Wide-field contact fundus photograph of an infant. 1240x1240px:
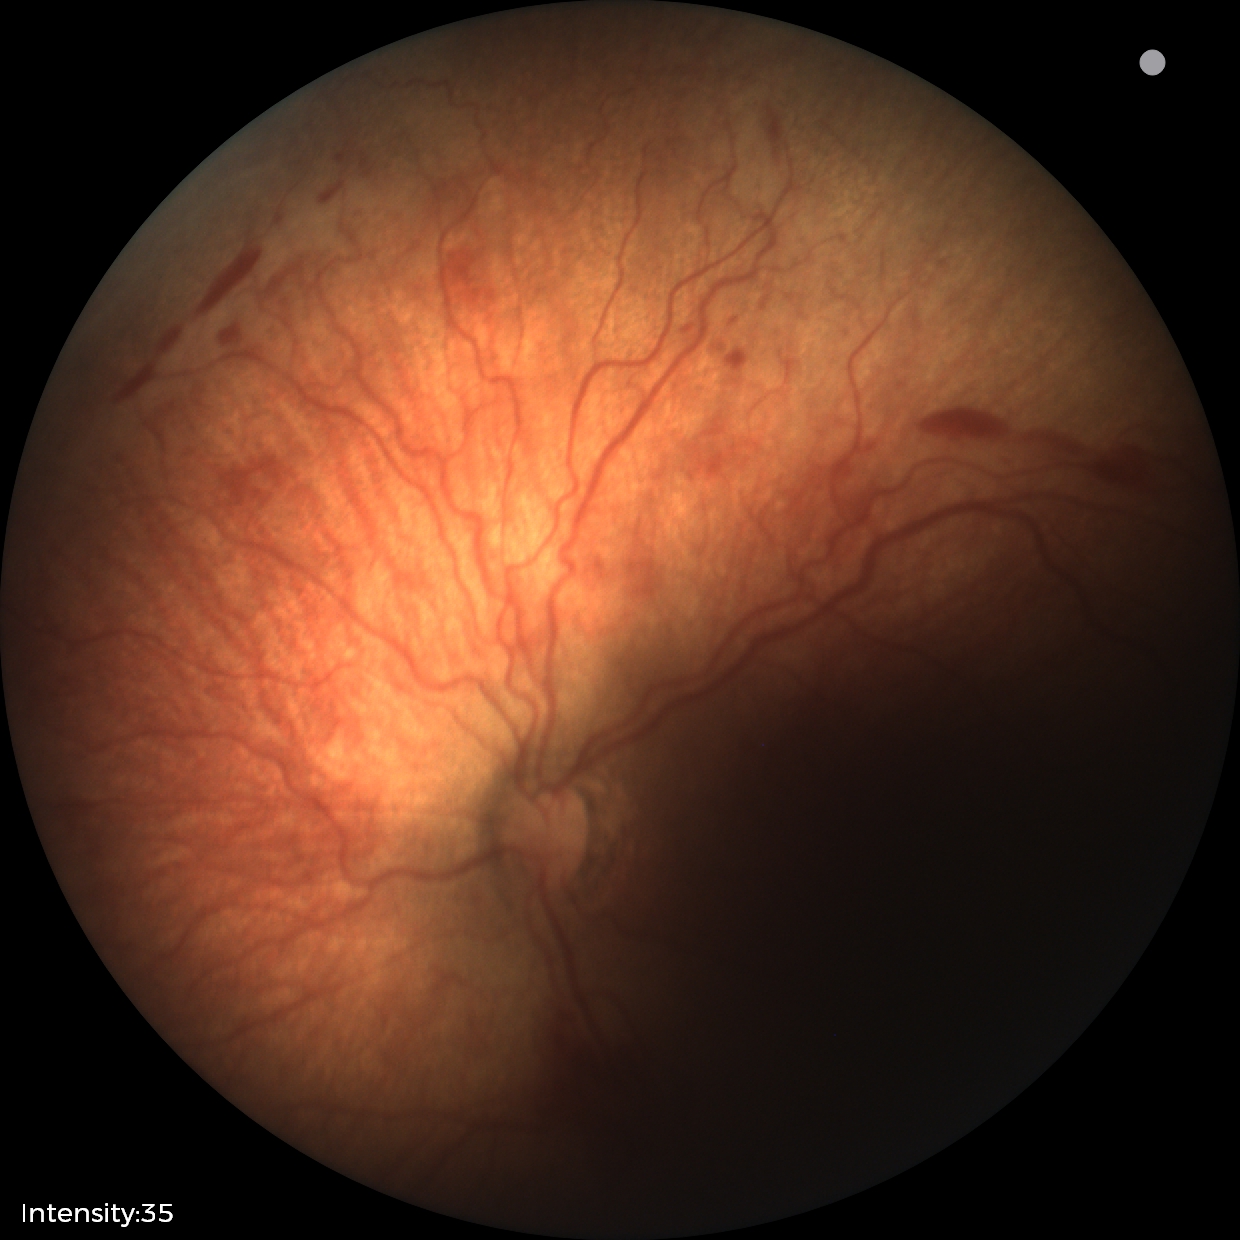

Q: What is the diagnosis from this examination?
A: retinopathy of prematurity (ROP) stage 2 — ridge with height and width at the demarcation line
Q: Plus disease status?
A: plus disease